798x752
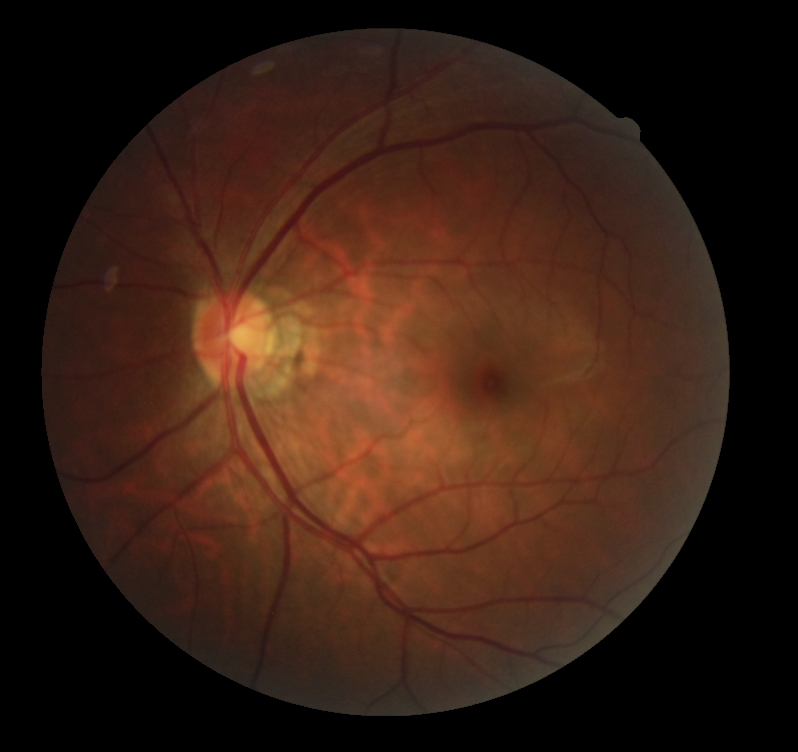 – diabetic retinopathy severity — grade 0 (no apparent retinopathy)
– DR impression — no apparent DR